Image size 640x480; wide-field fundus photograph from neonatal ROP screening: 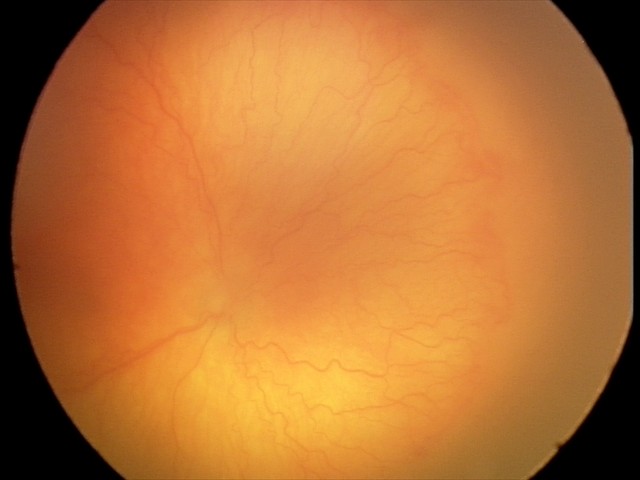

Assessment: A-ROP (aggressive ROP); plus disease.